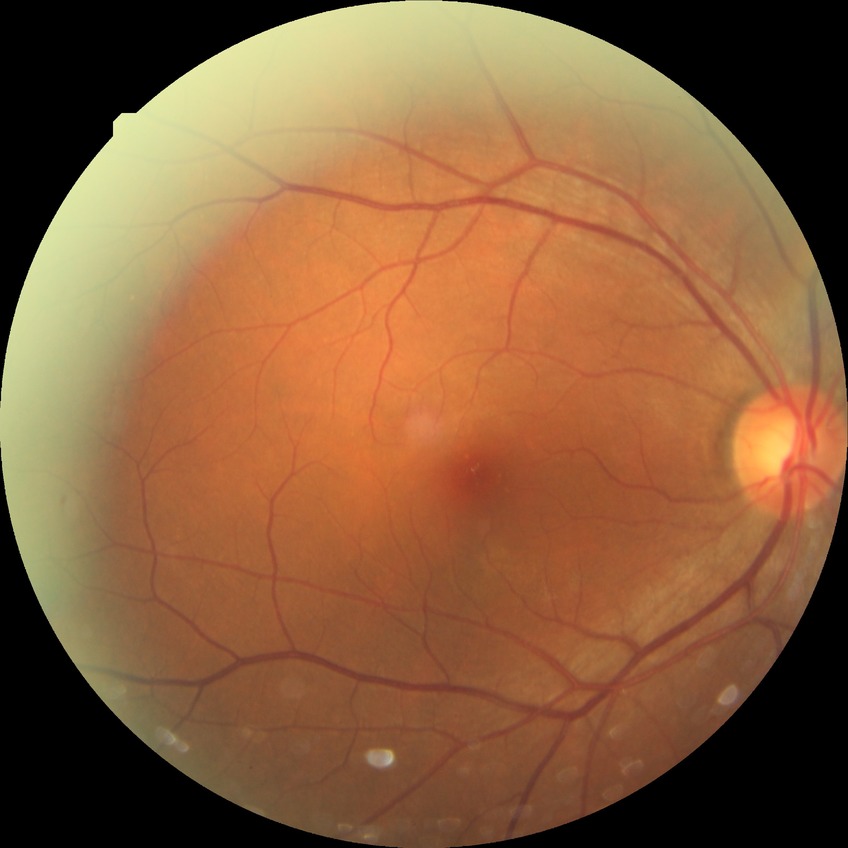

Assessment:
• modified Davis classification: no diabetic retinopathy